CFP, 45° FOV, 2352 x 1568 pixels
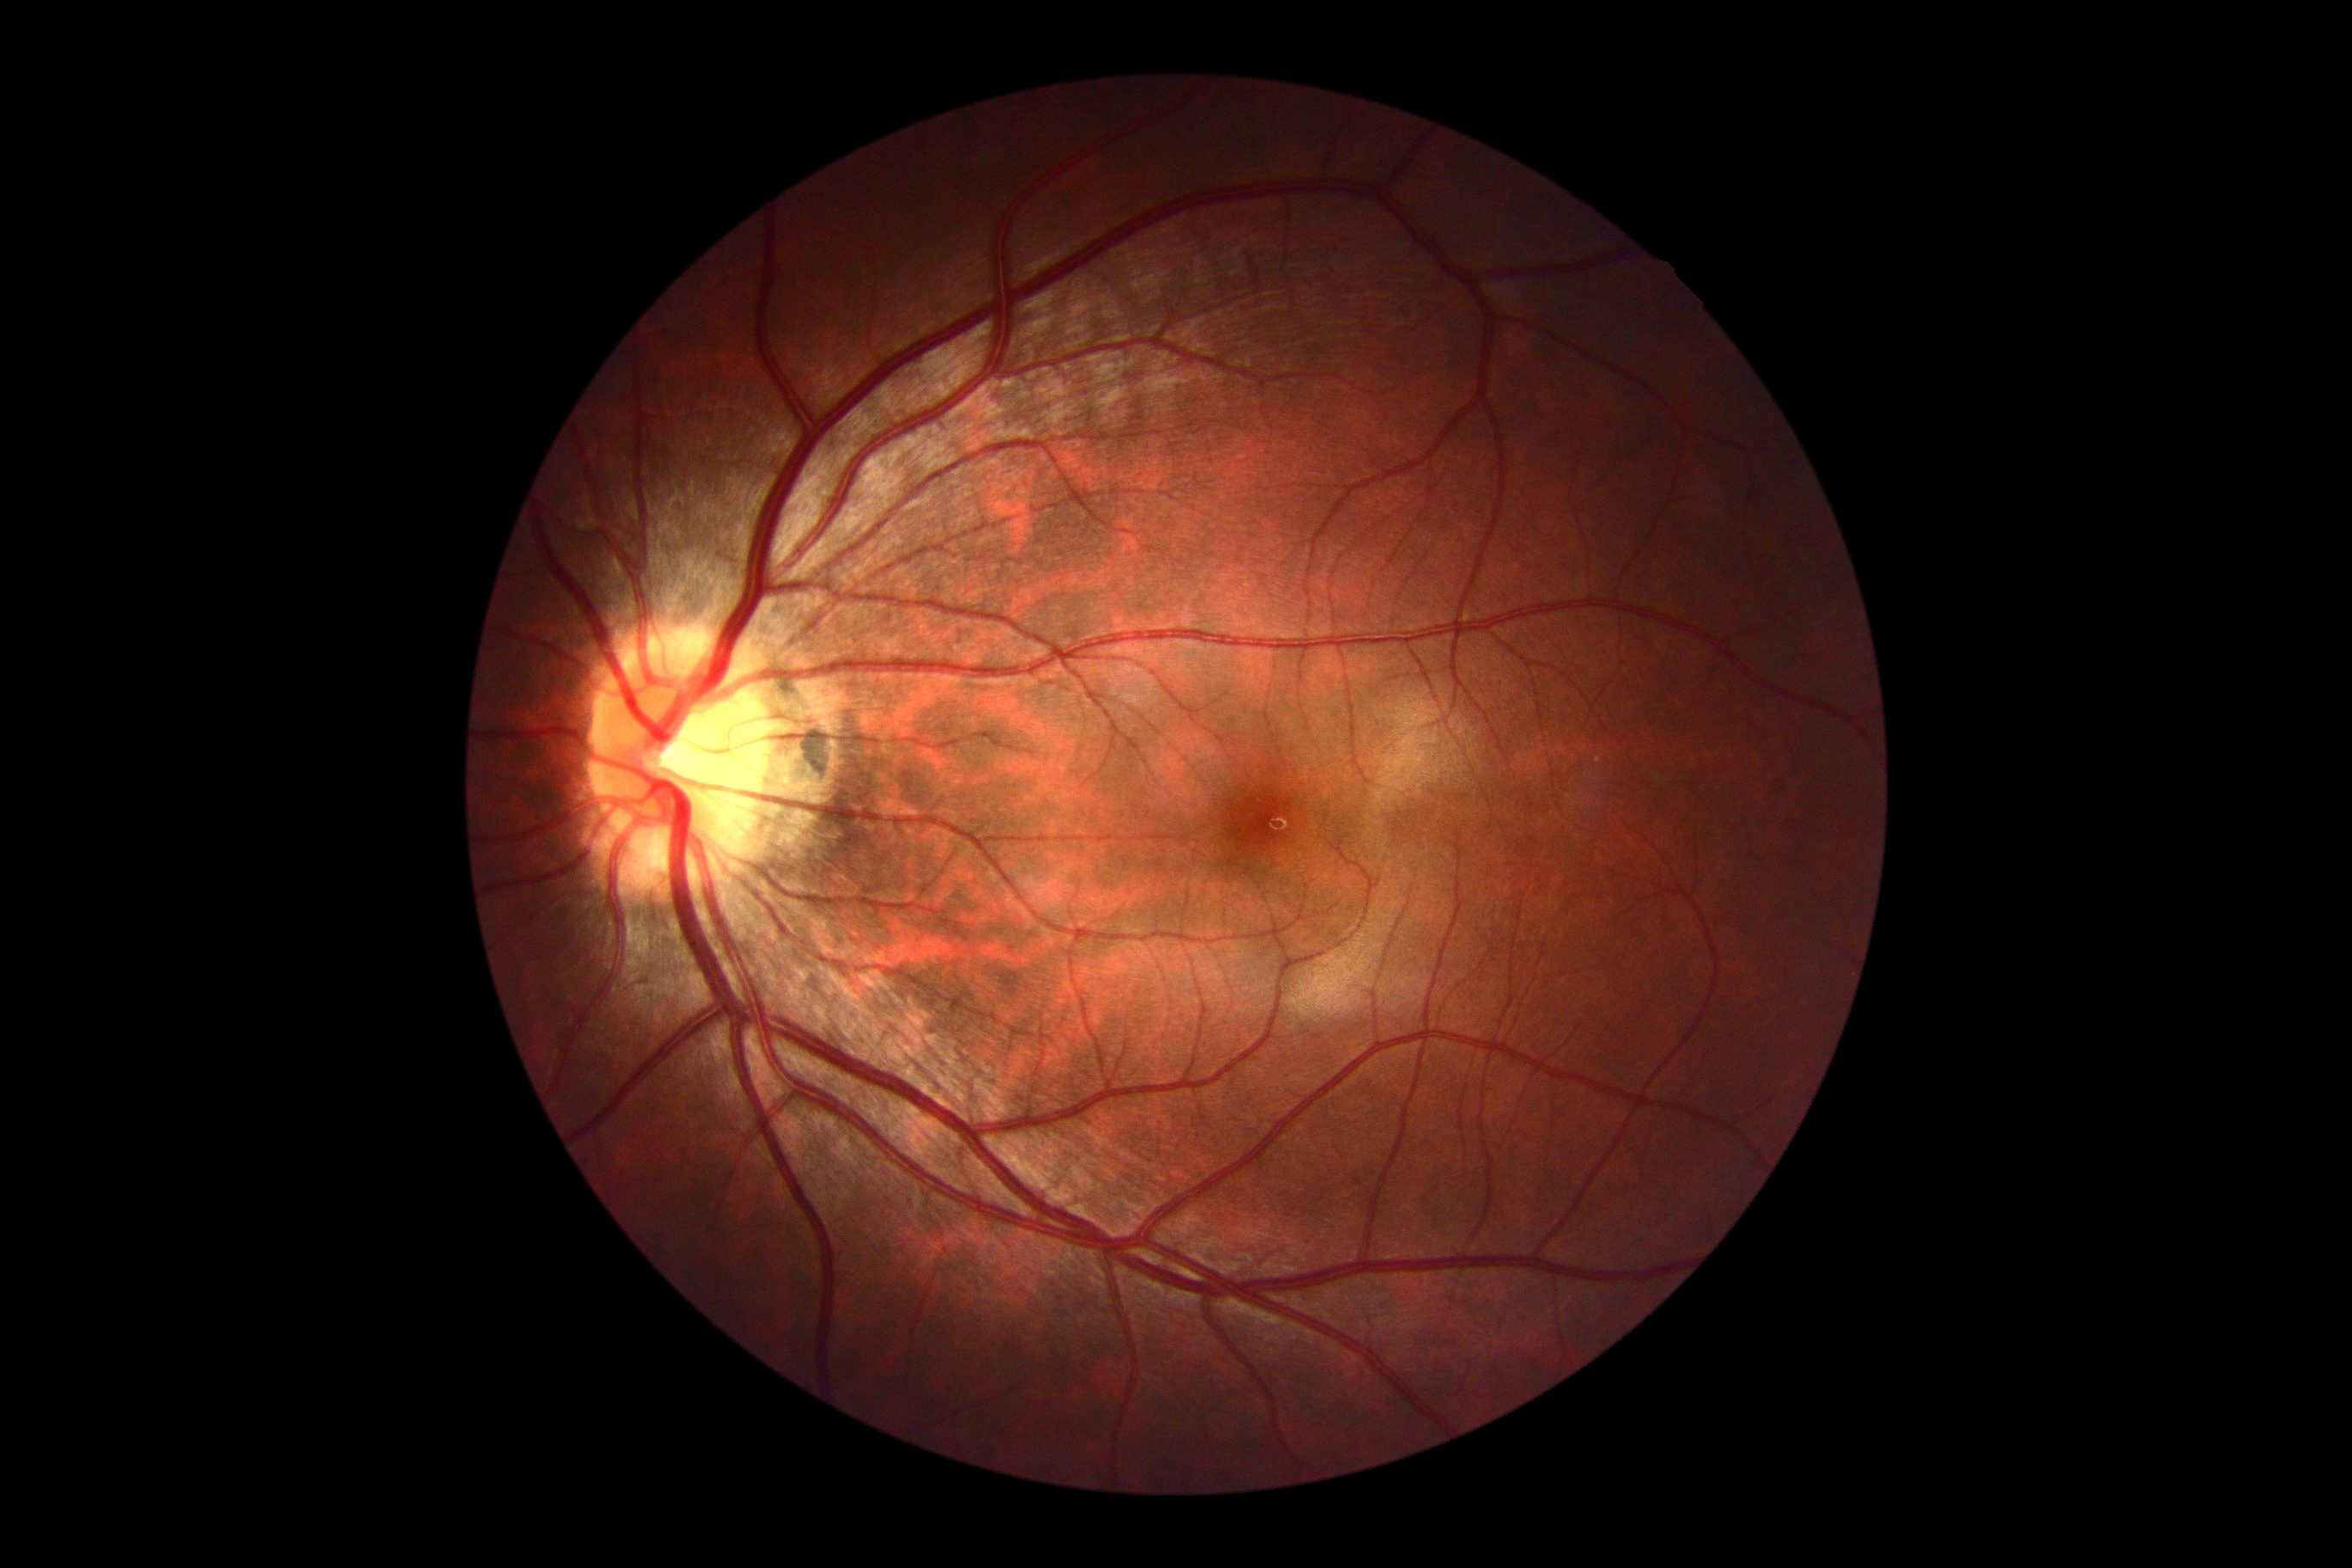

DR impression=no DR findings; diabetic retinopathy severity=no apparent retinopathy (grade 0).